Posterior pole view, 2228x1652, acquired with a Topcon TRC-50DX.
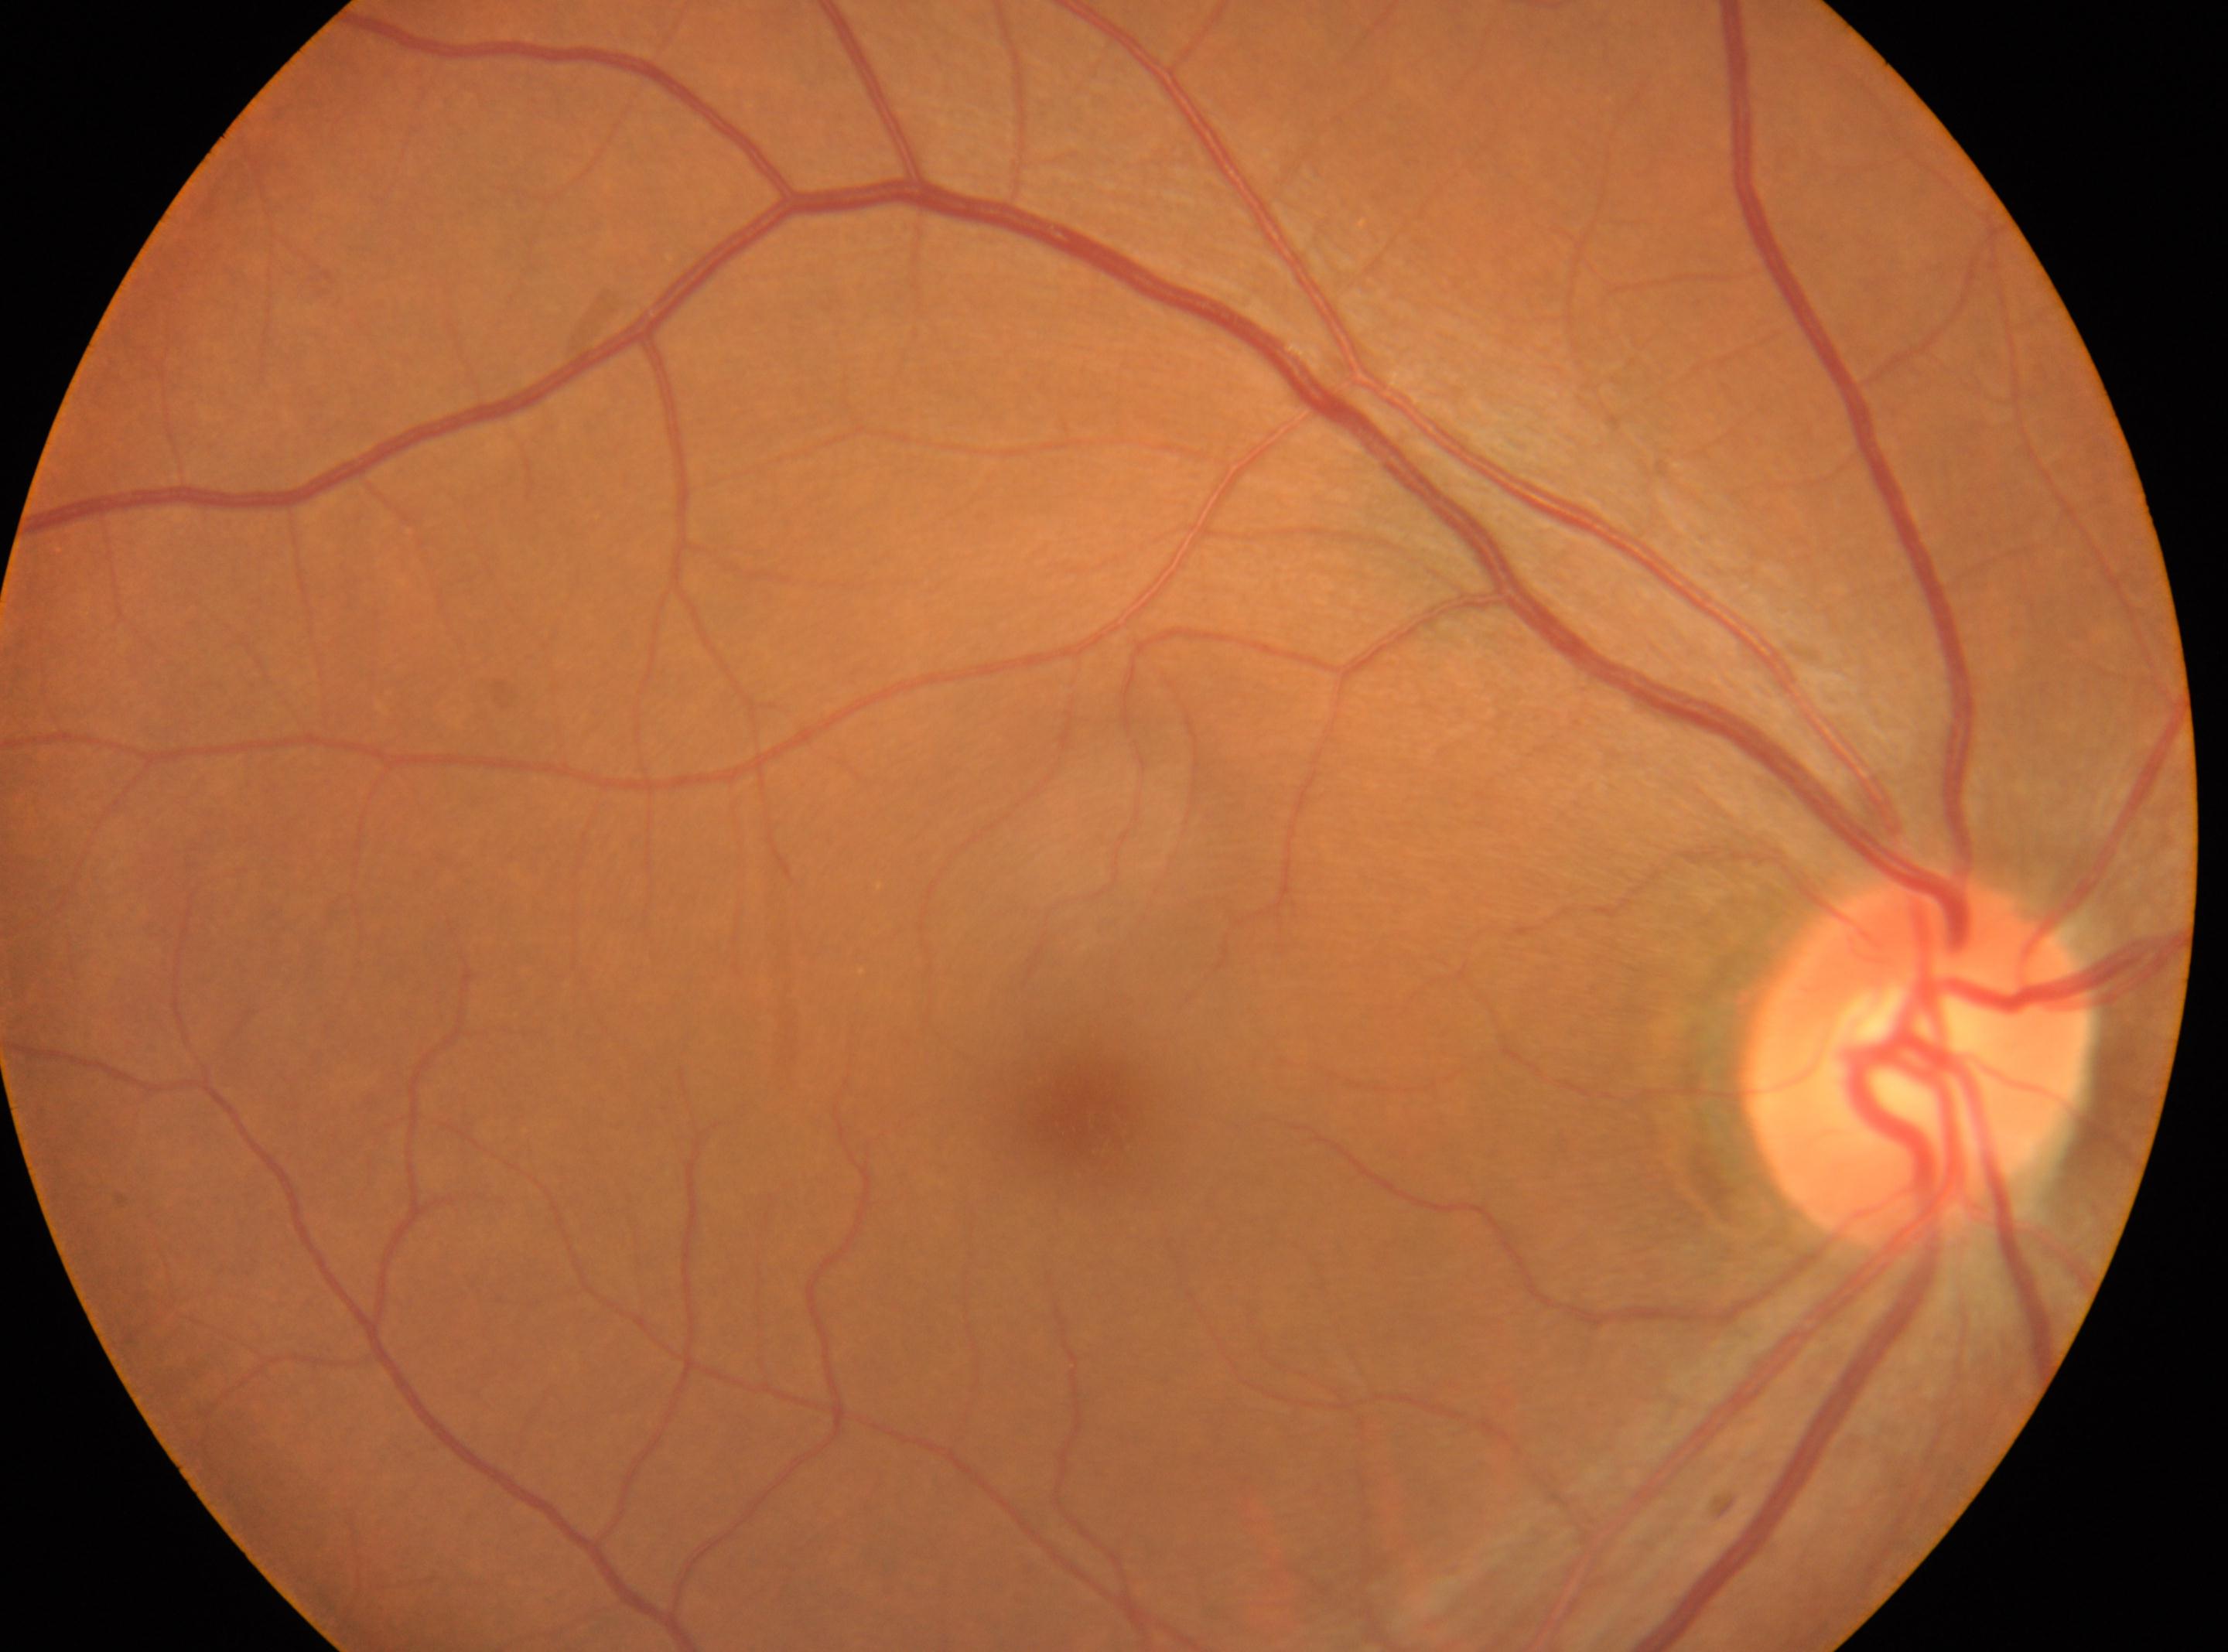 Imaged eye: right eye.
Retinopathy grade is 0 (no apparent retinopathy).
Macular center located at (x=1088, y=1118).
Optic disc located at (x=1917, y=1060).